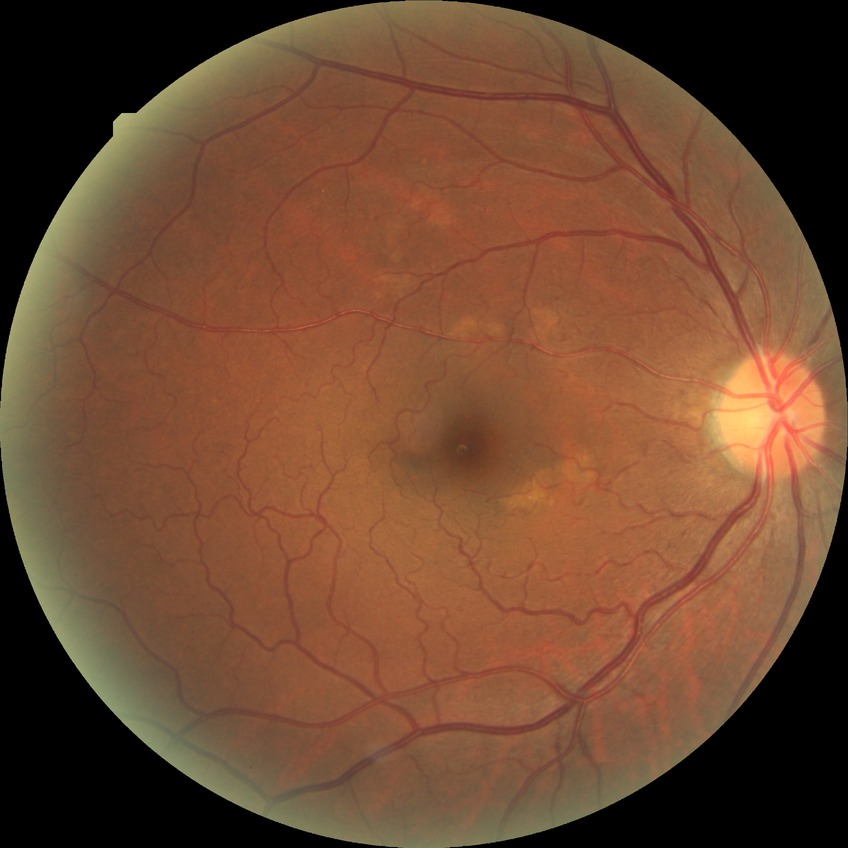 davis_grade: no diabetic retinopathy